200° field of view · wide-field retinal mosaic image — 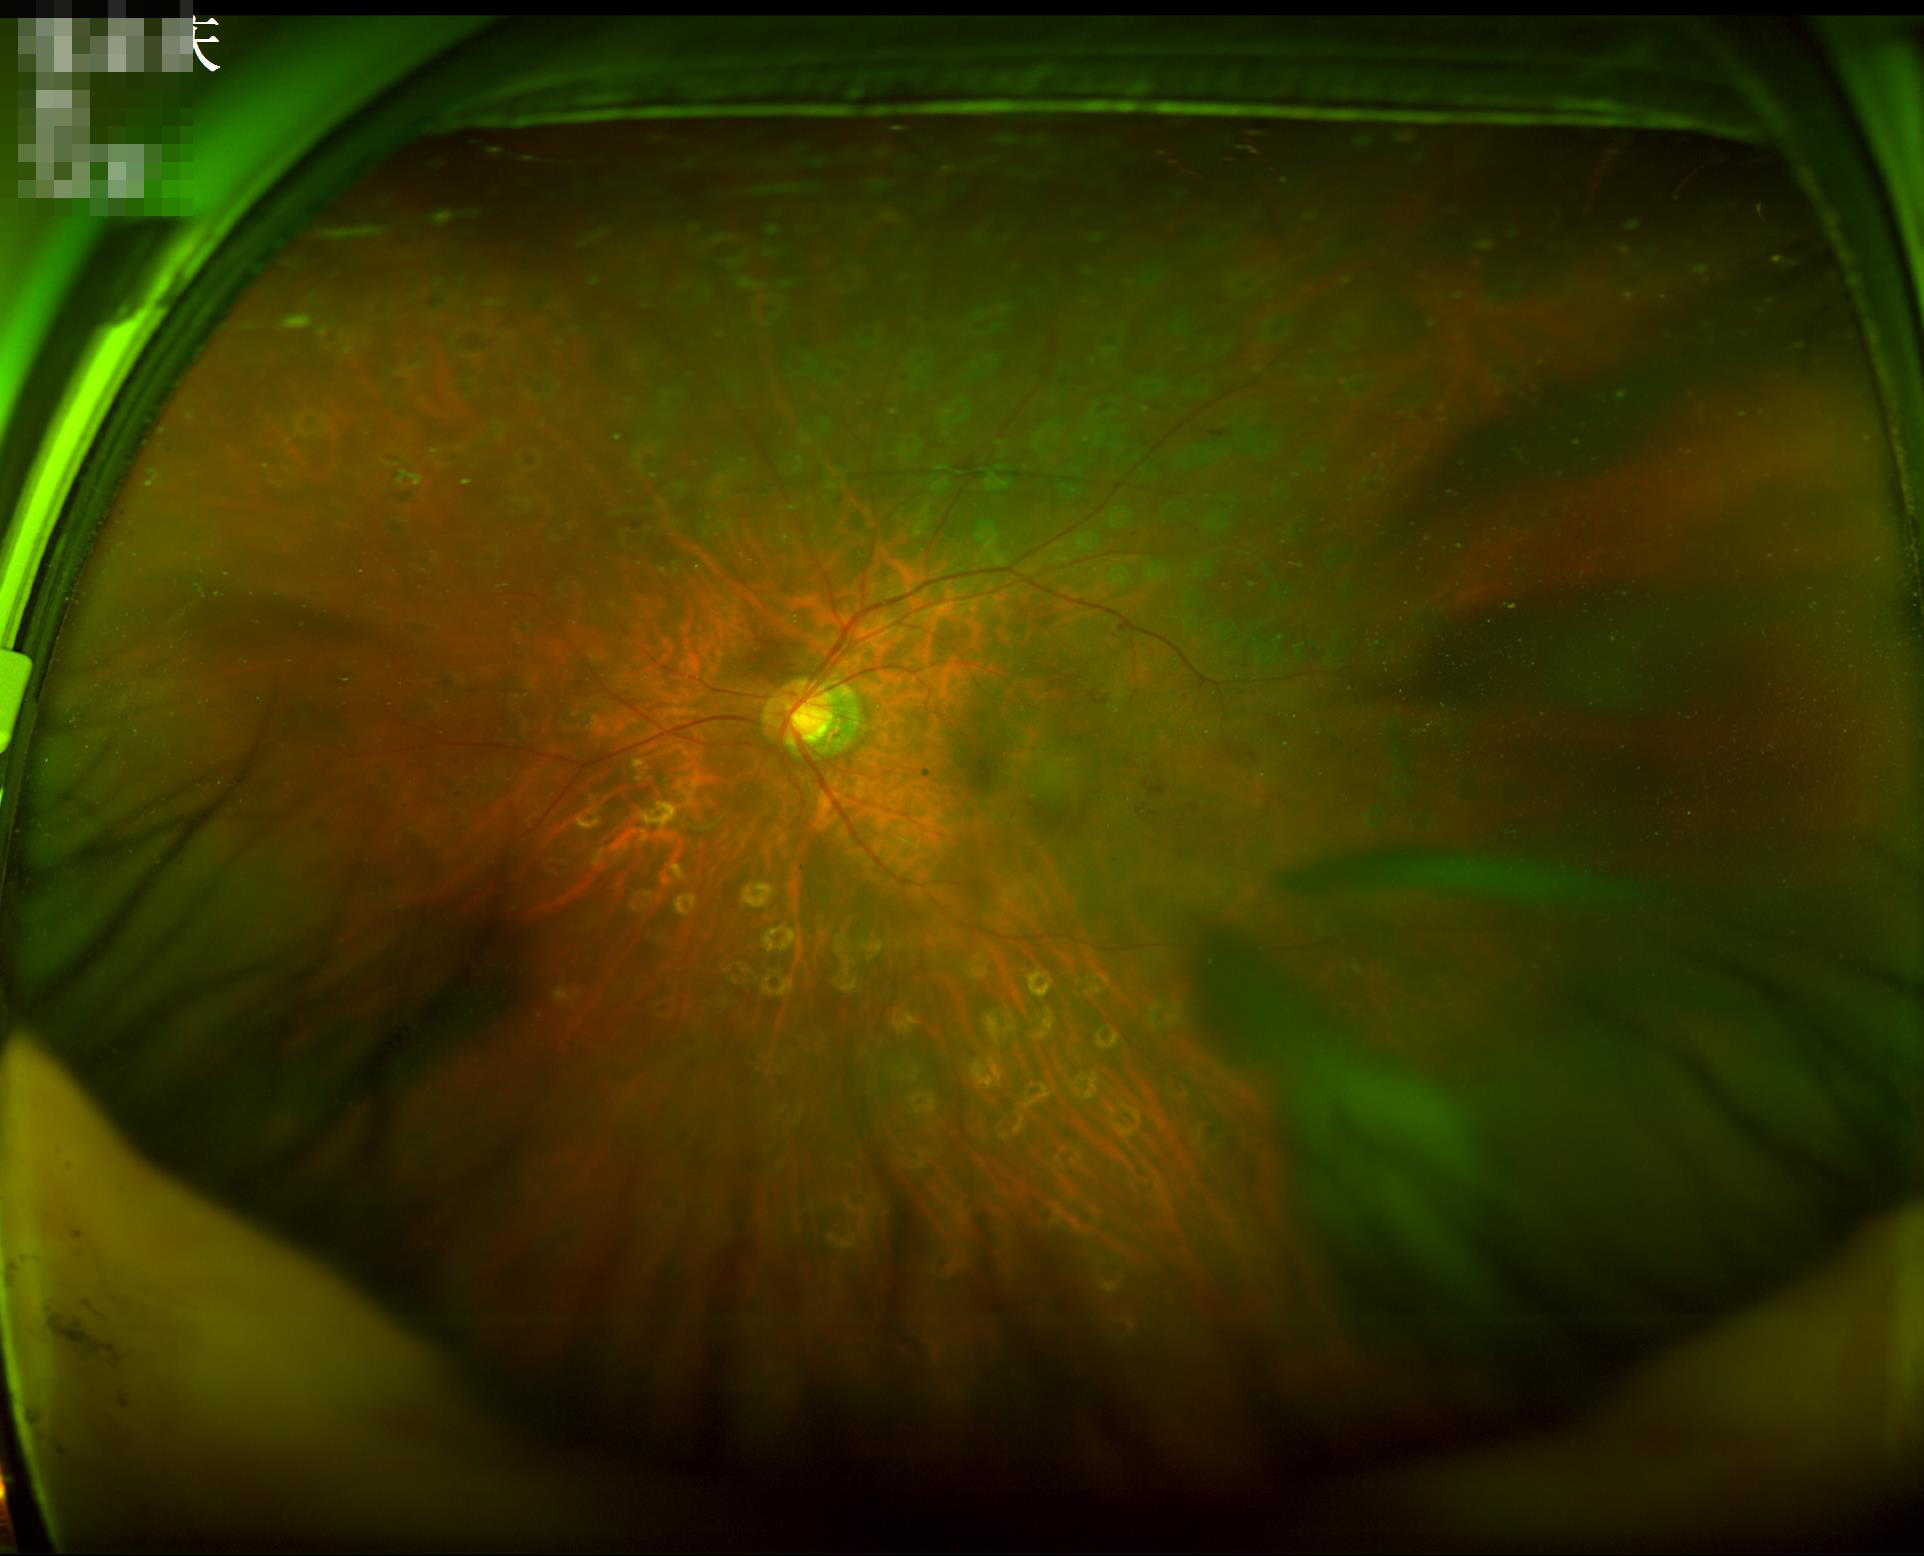

clarity: noticeable blur in the optic disc, vessels, or background
illumination: uneven illumination or color cast
overall_quality: poor, ungradable